Pediatric retinal photograph (wide-field) · 130° field of view (Natus RetCam Envision).
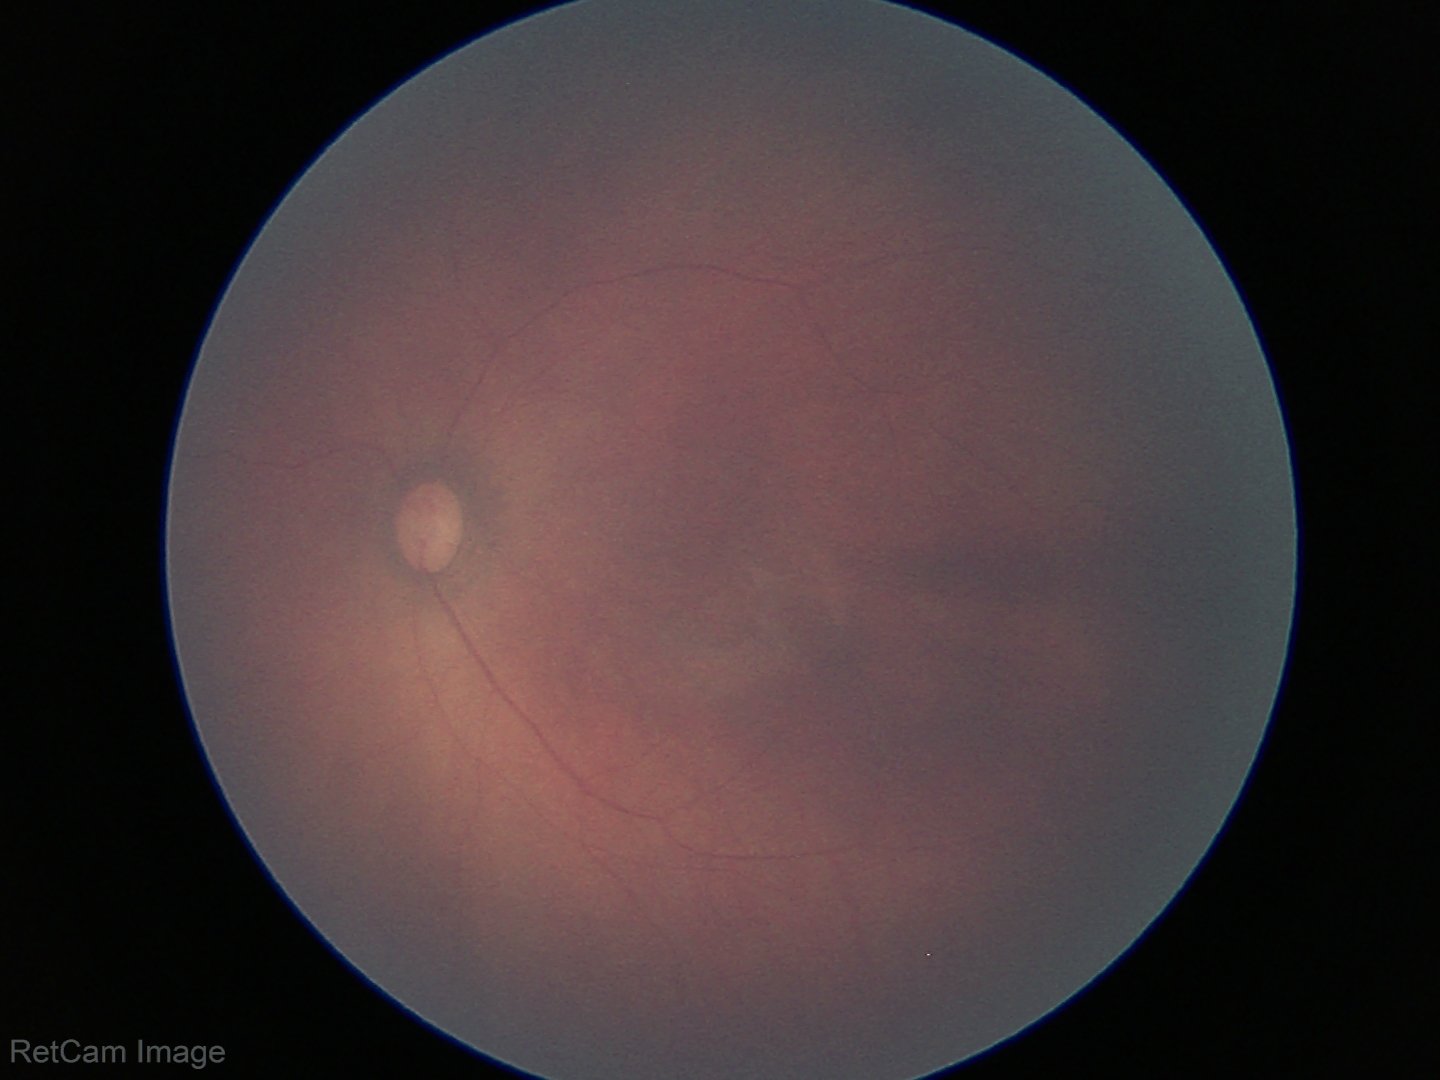

Assessment = physiological